Color fundus image:
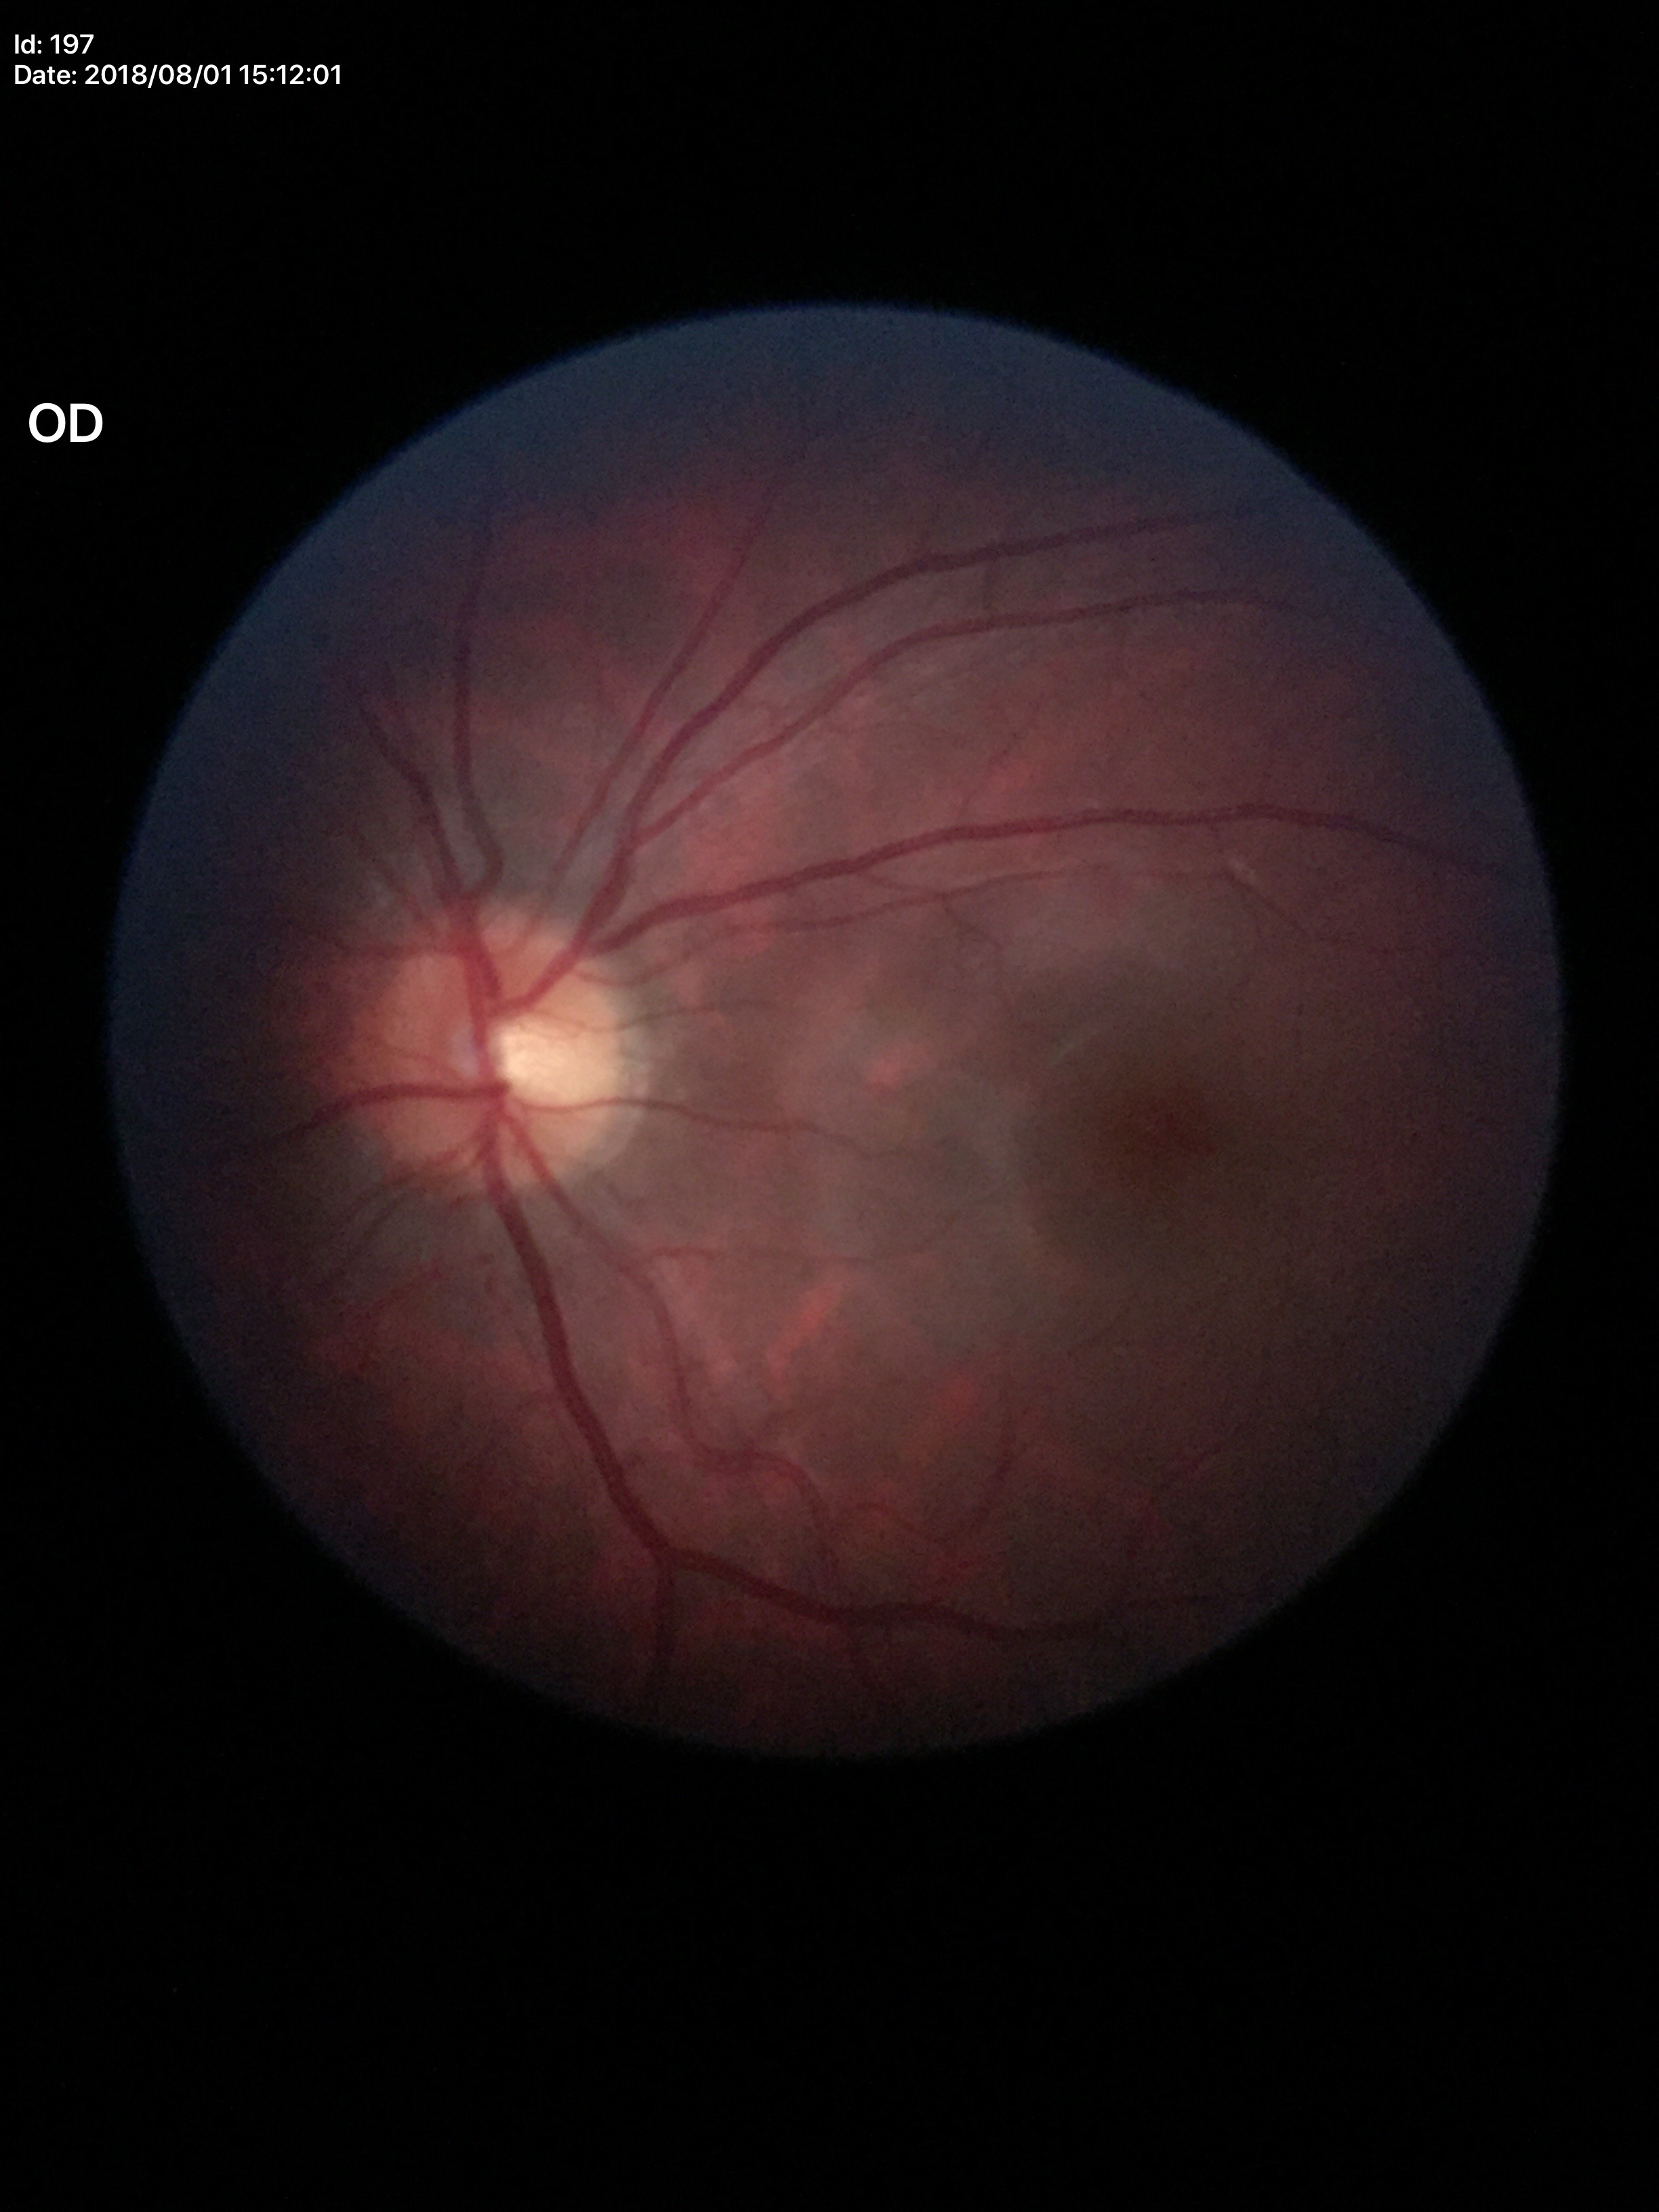 Glaucoma screening impression: not suspect (5/5 ophthalmologists in agreement). VCDR is 0.50.